Retinal fundus photograph: 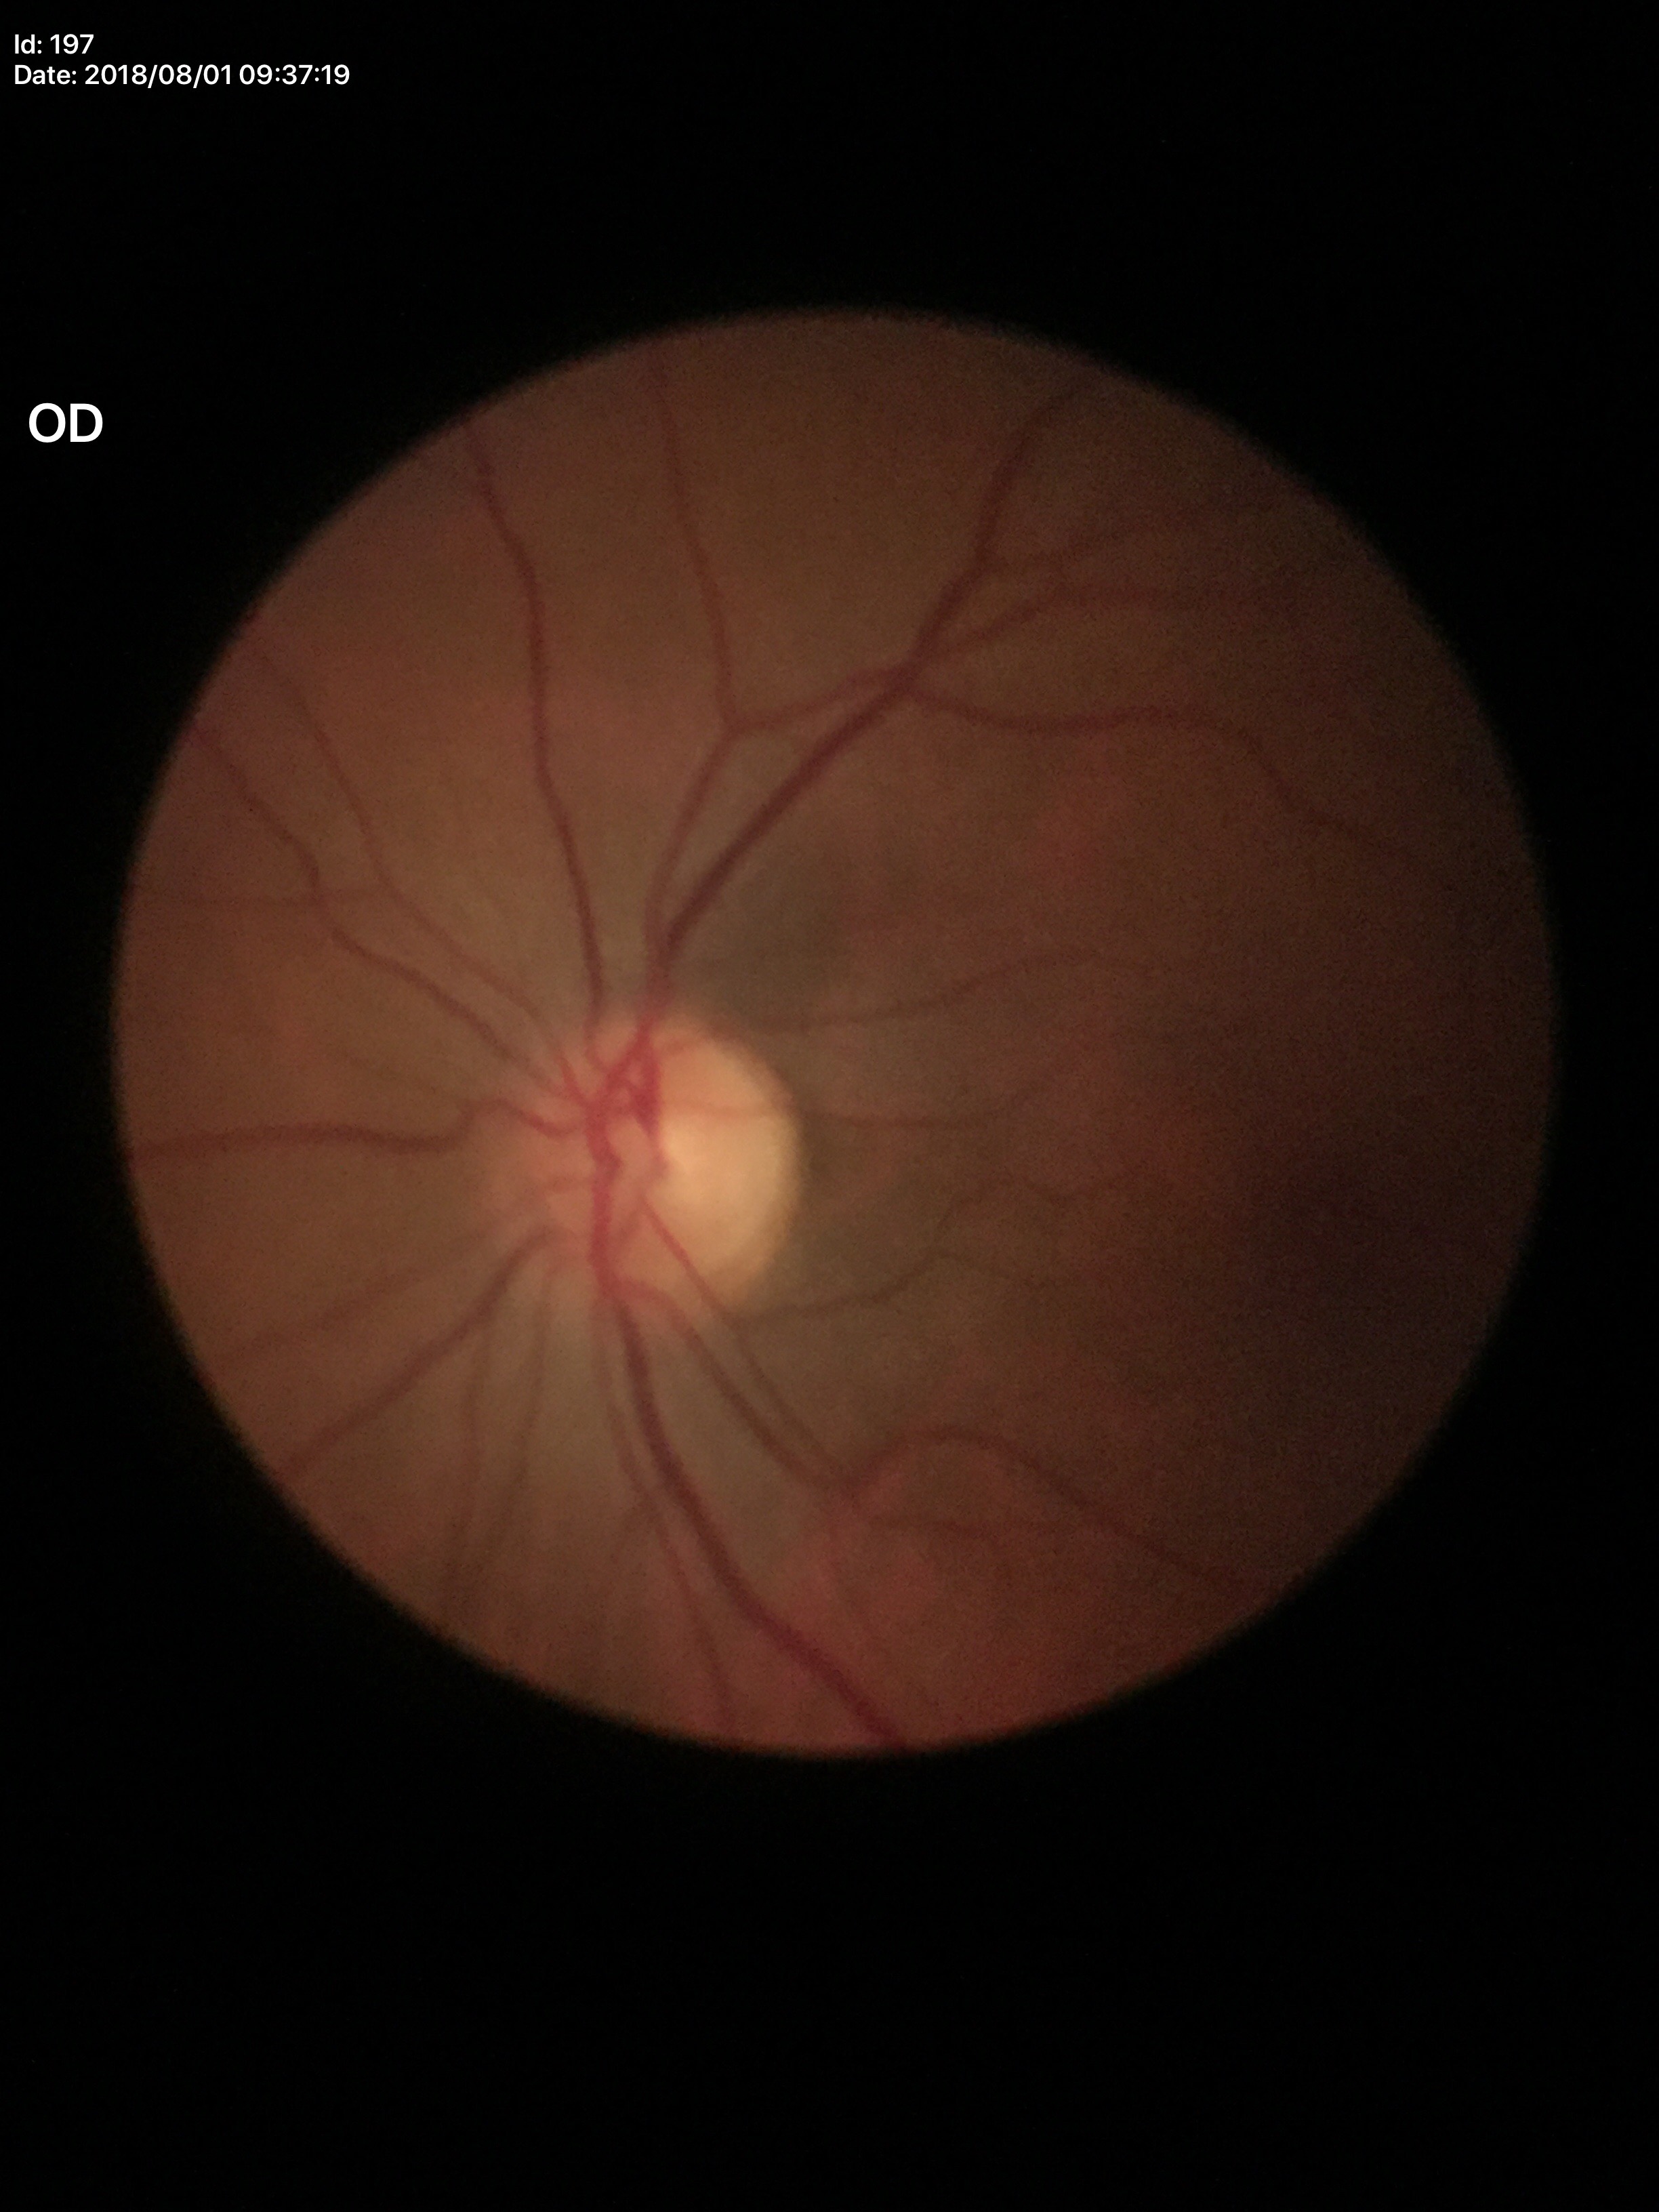
Glaucoma decision: negative.
Vertical cup-to-disc ratio (VCDR) of 0.47.
Horizontal CDR (HCDR) of 0.45.